45-degree field of view.
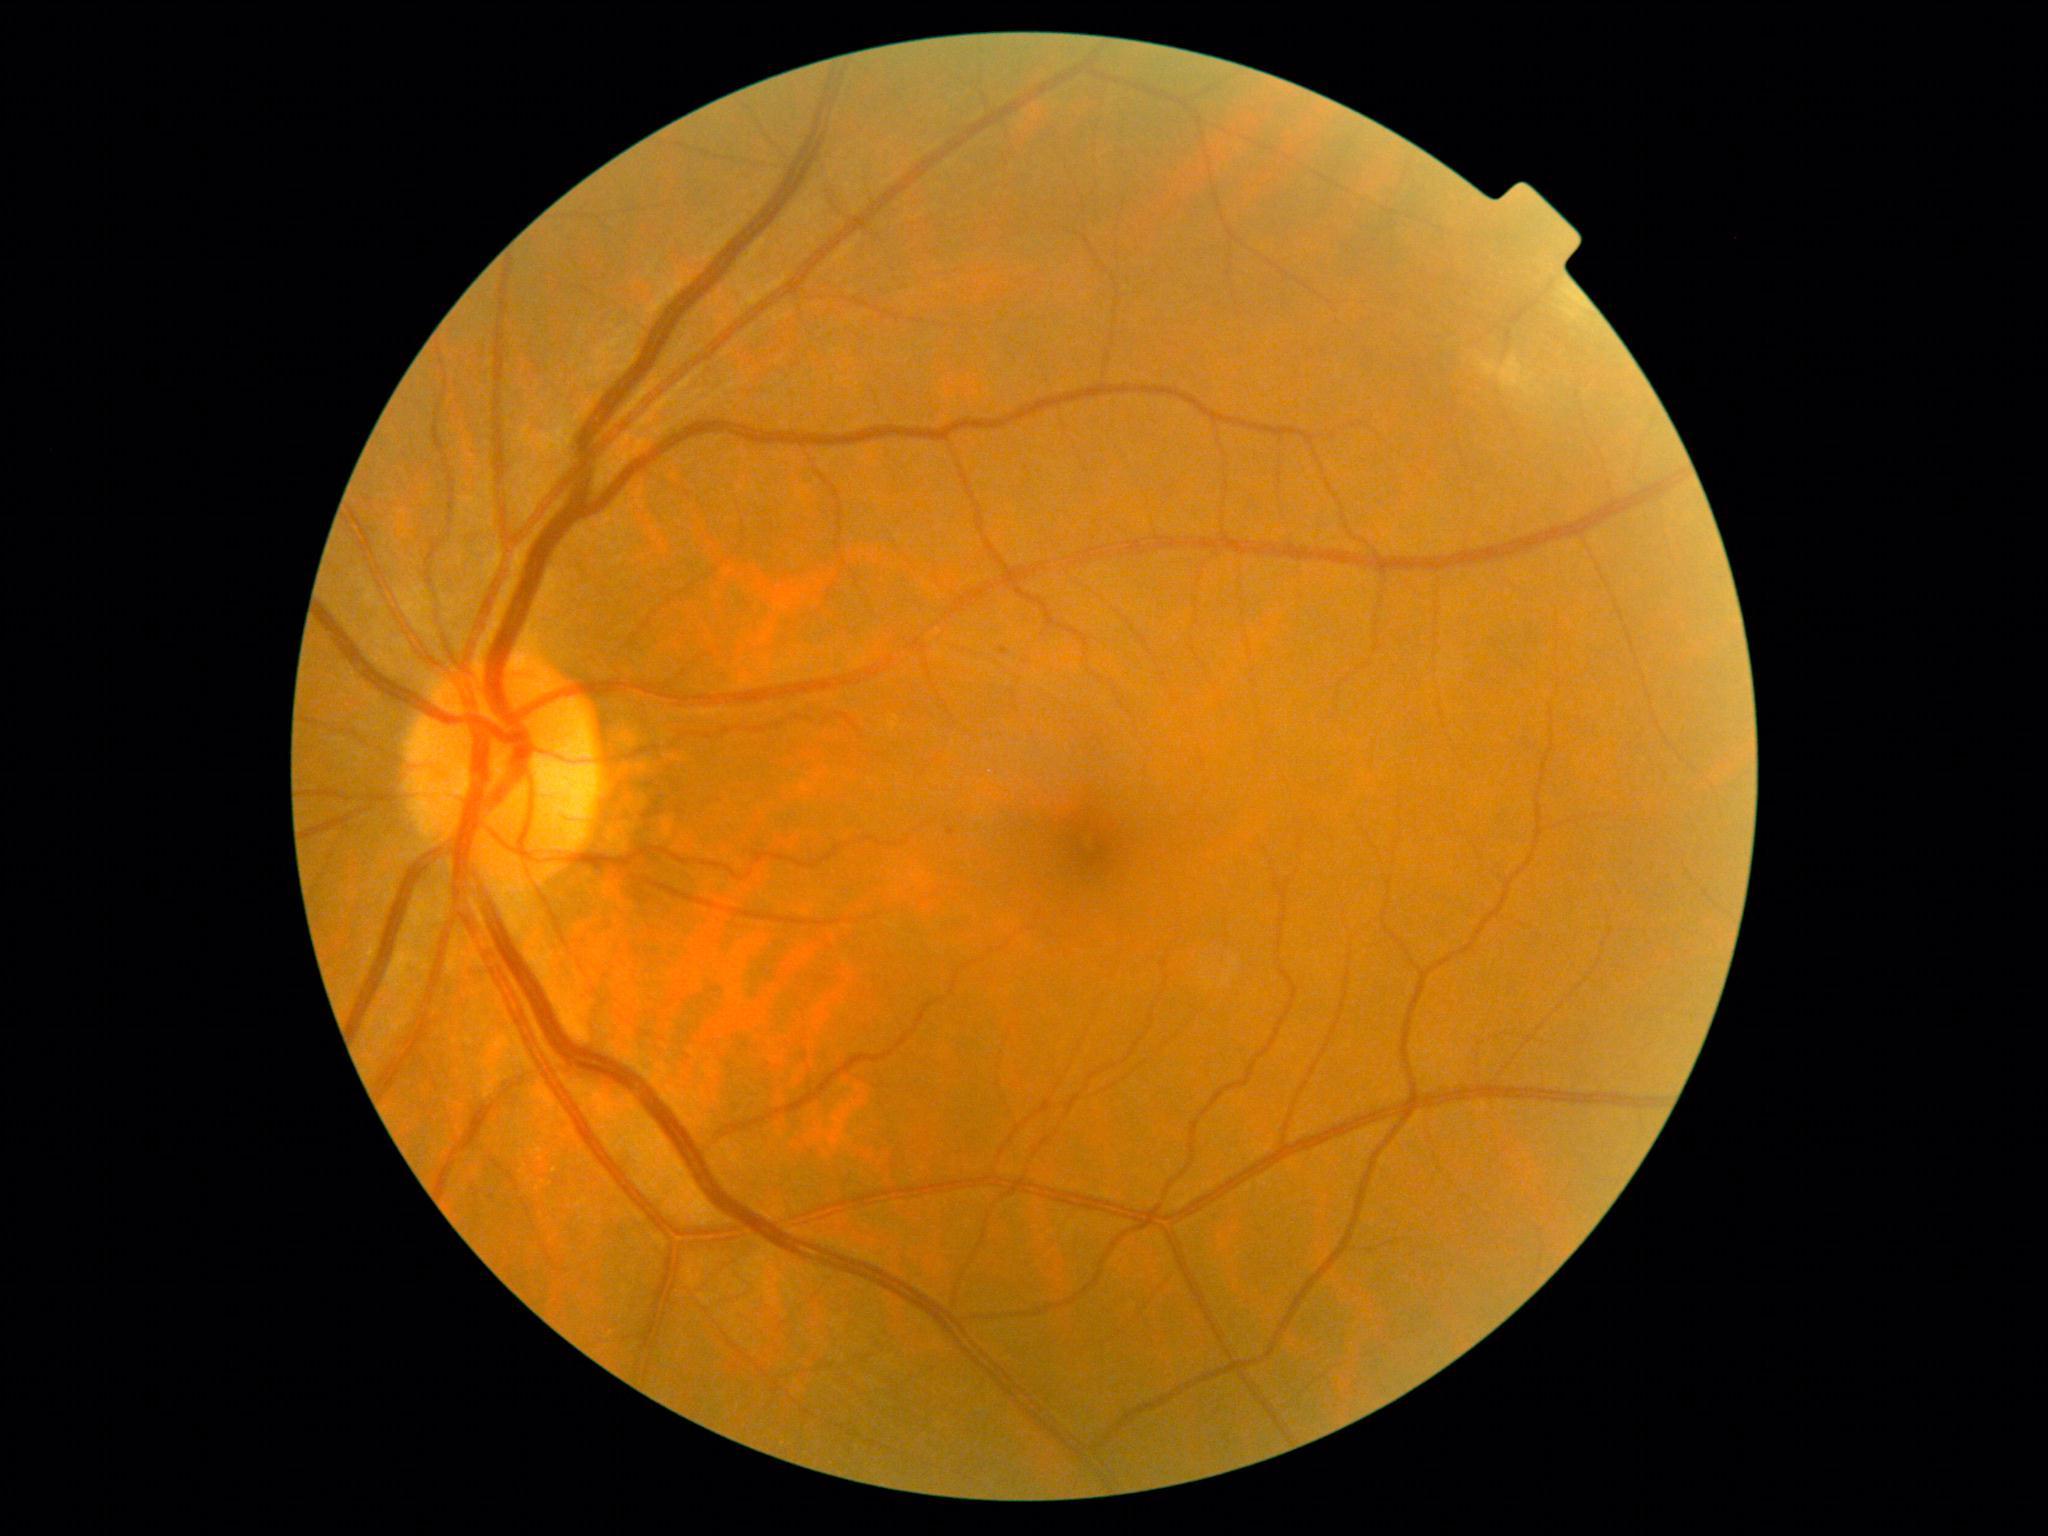
Retinopathy grade: 1.